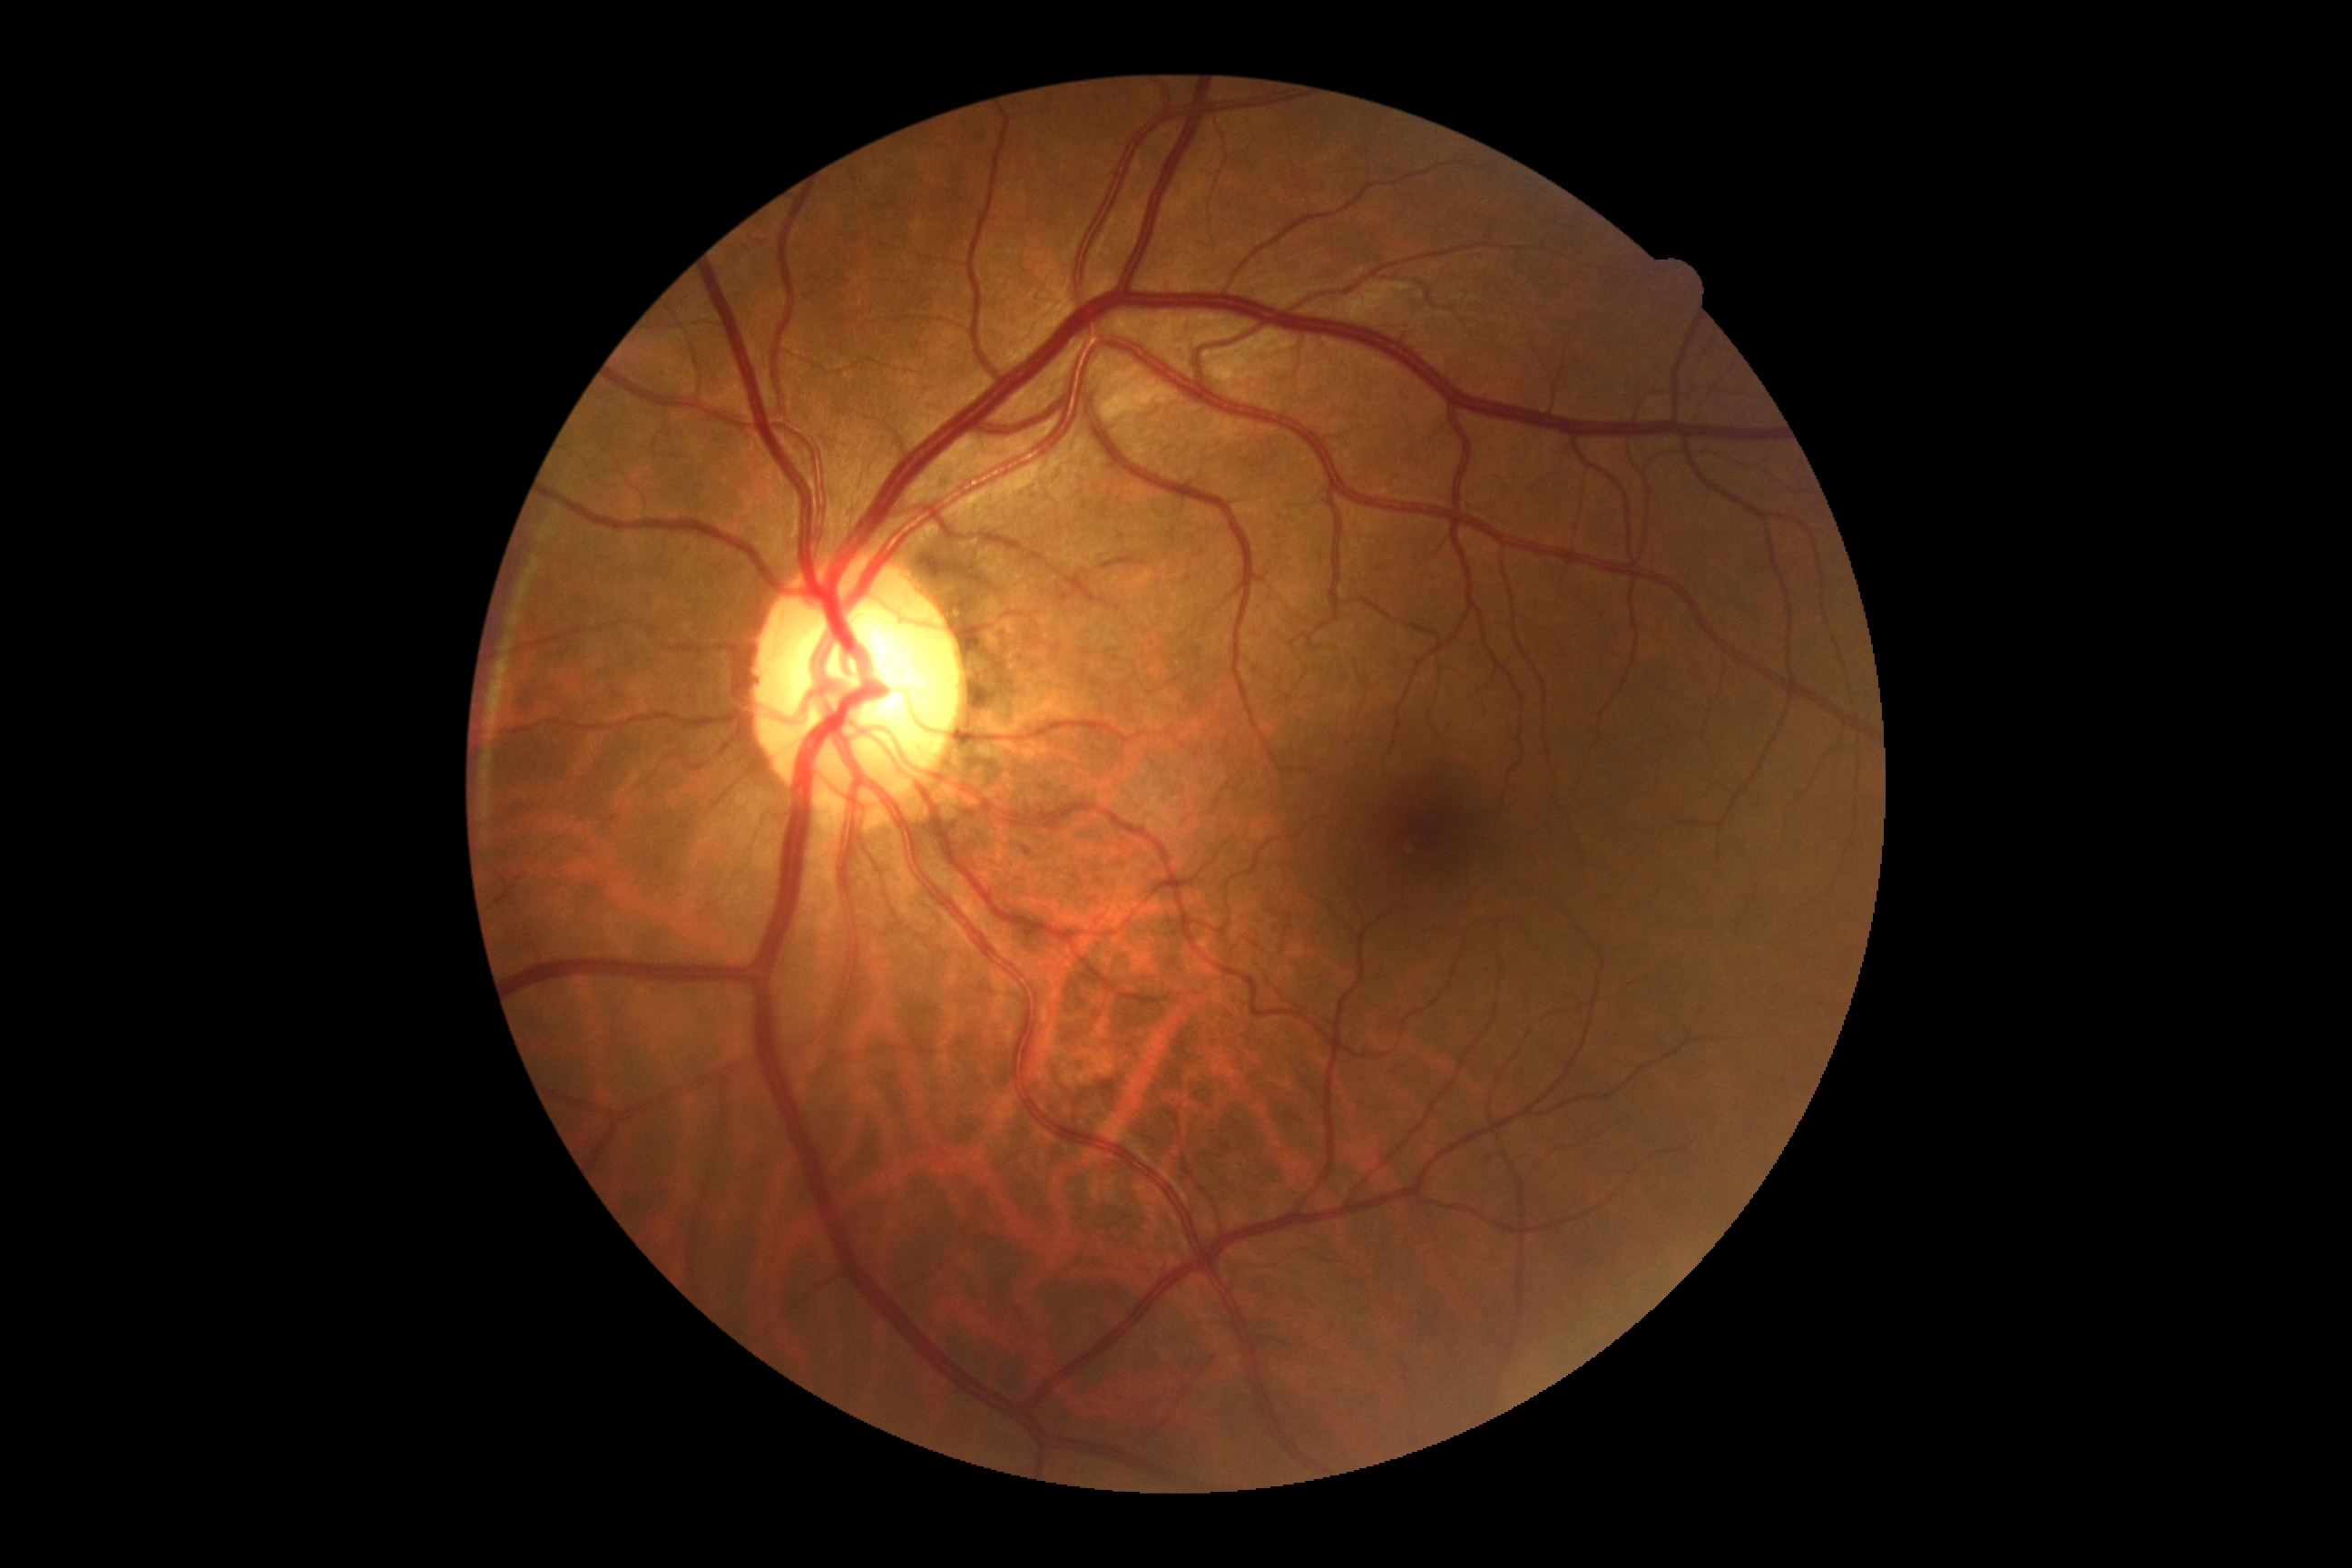 diabetic retinopathy: 0